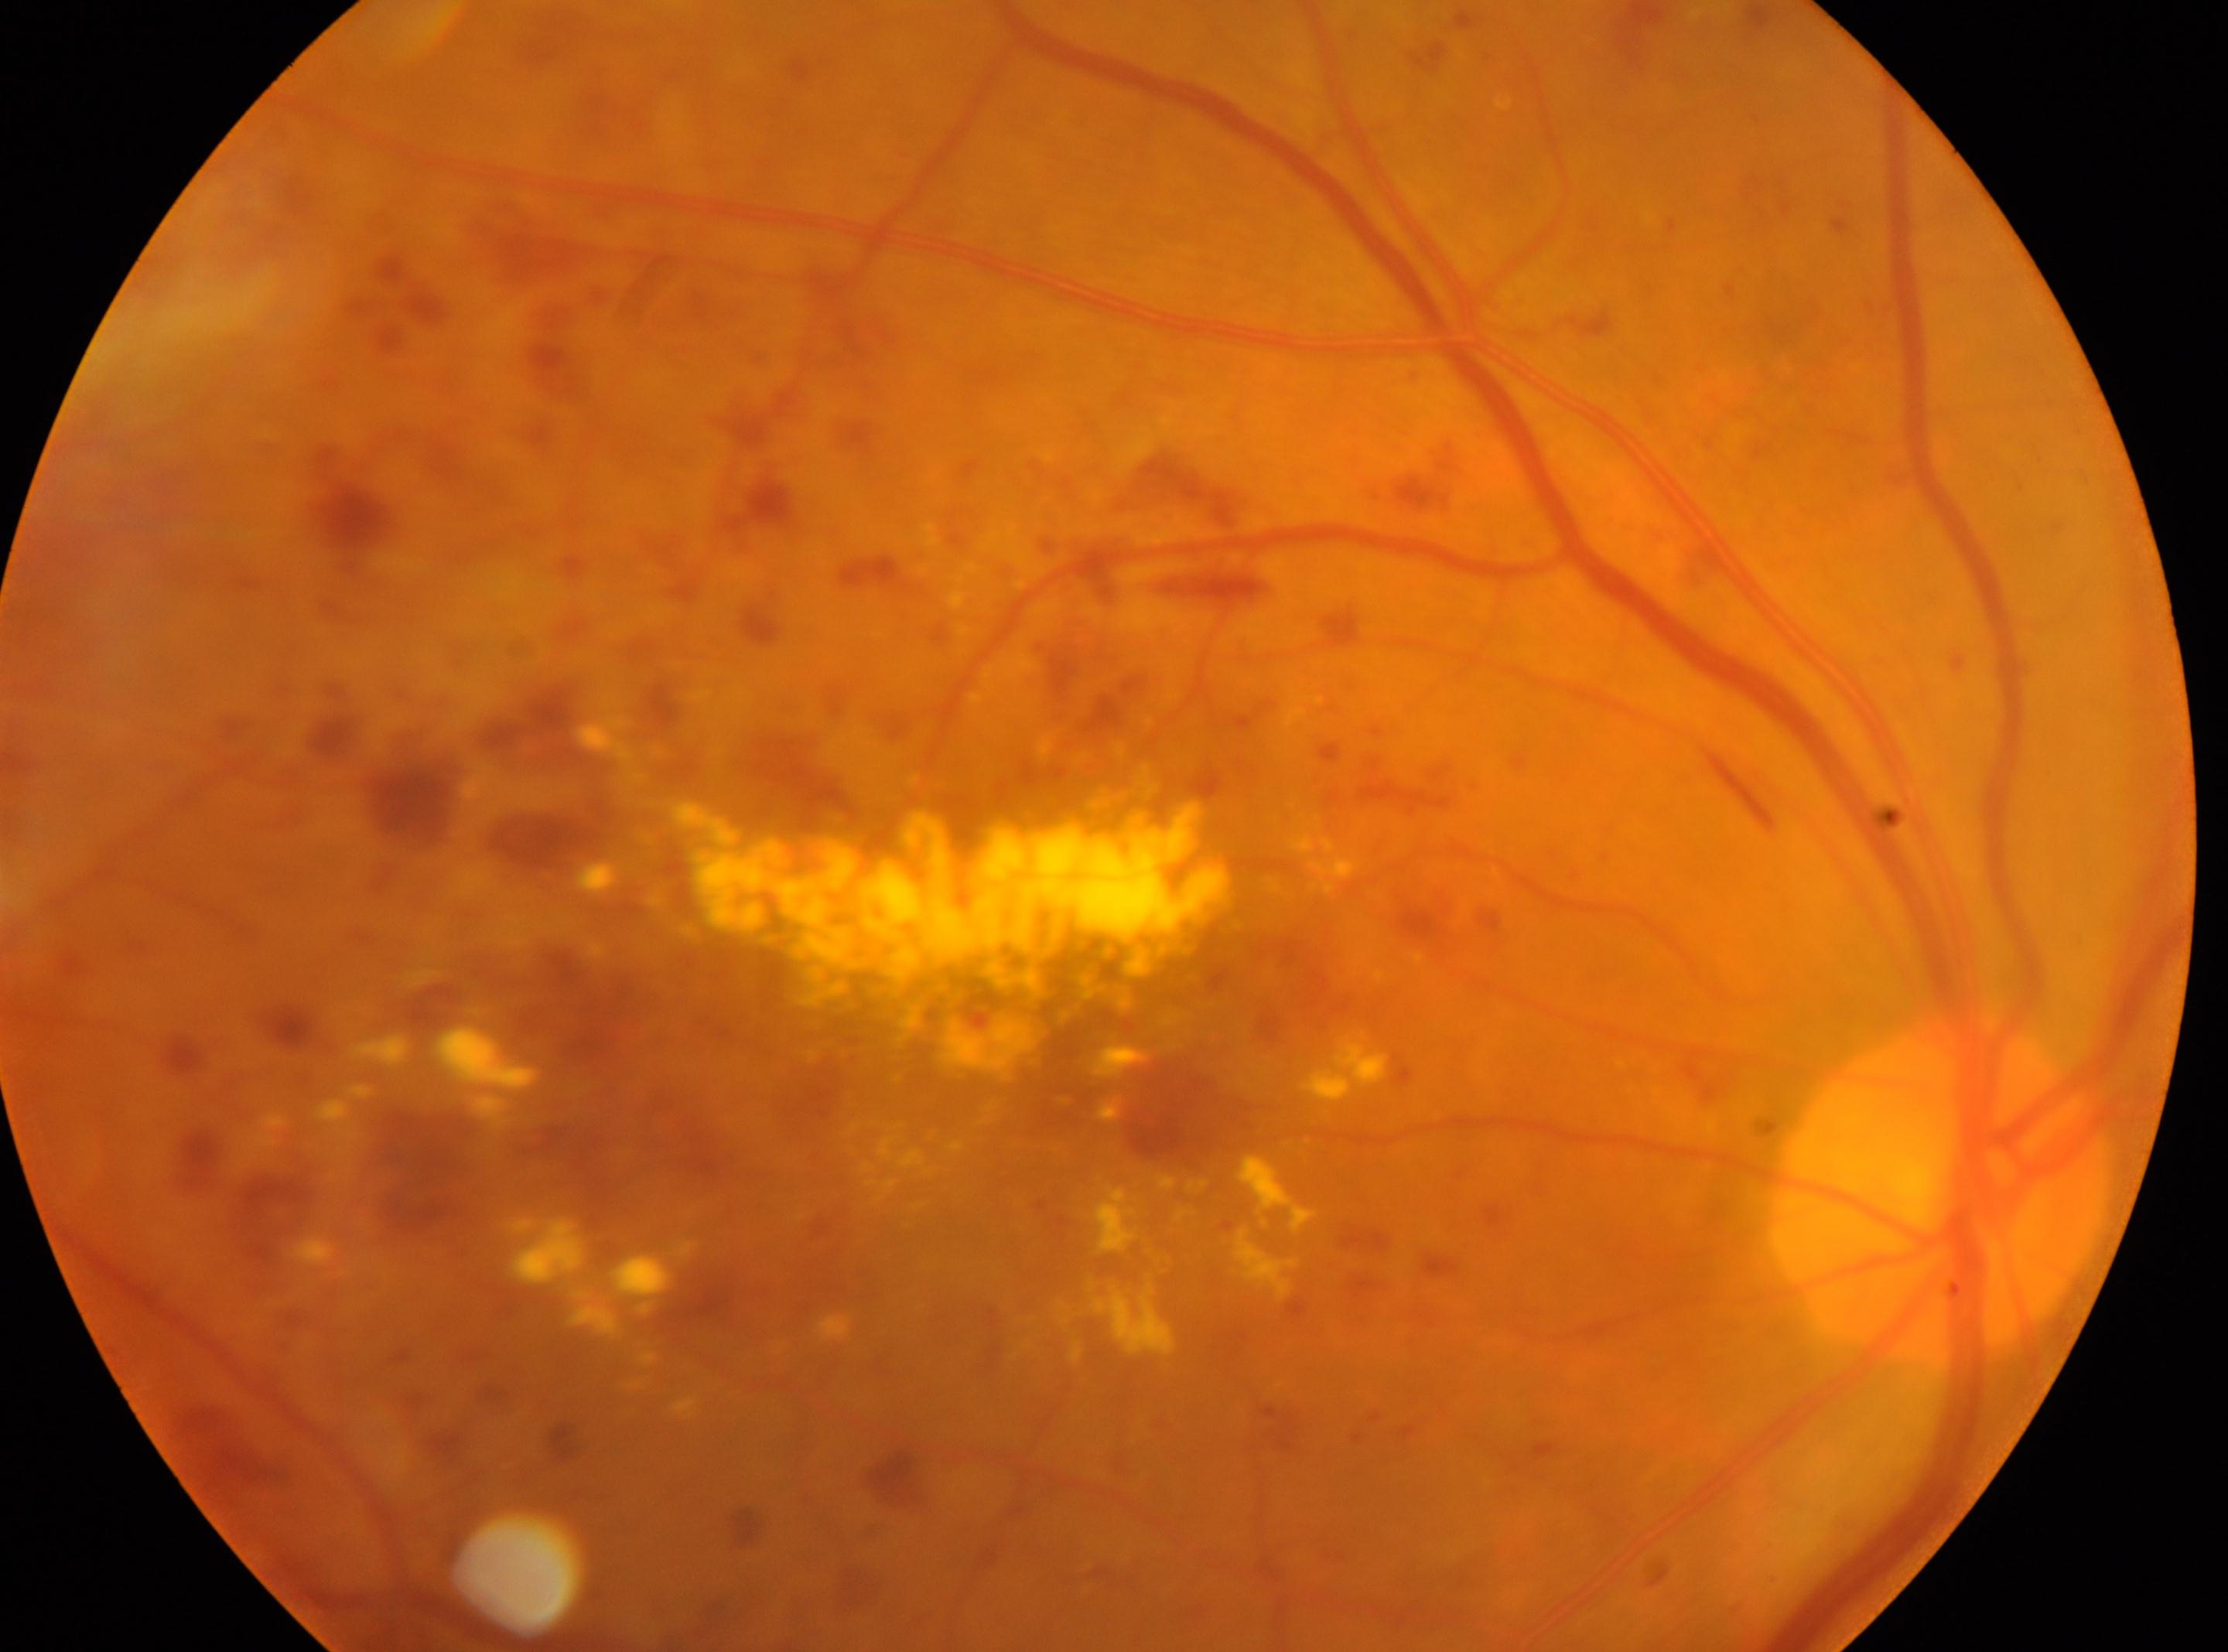
{"optic_disc": "(x=1937, y=1188)", "fovea": "(x=1069, y=1083)", "dr_grade": "3 (severe NPDR) — more than 20 intraretinal hemorrhages in each of 4 quadrants, definite venous beading in 2 or more quadrants, or prominent intraretinal microvascular abnormalities in 1 or more quadrants, with no signs of proliferative retinopathy", "eye": "the right eye"}